Wide-field fundus photograph from neonatal ROP screening: 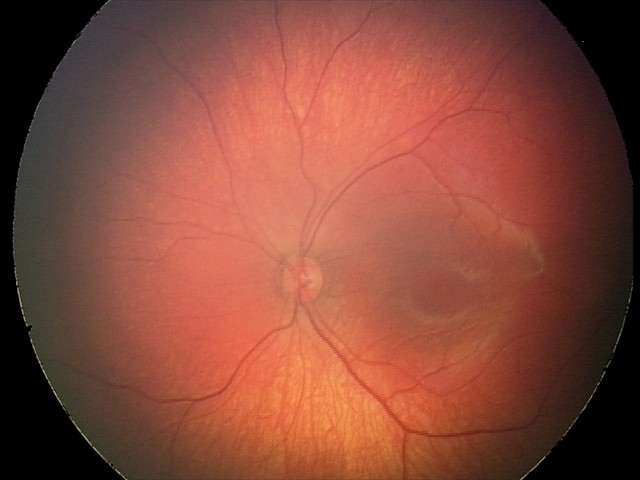 Screening diagnosis: retinal hemorrhages.